CFP, NIDEK AFC-230 fundus camera: 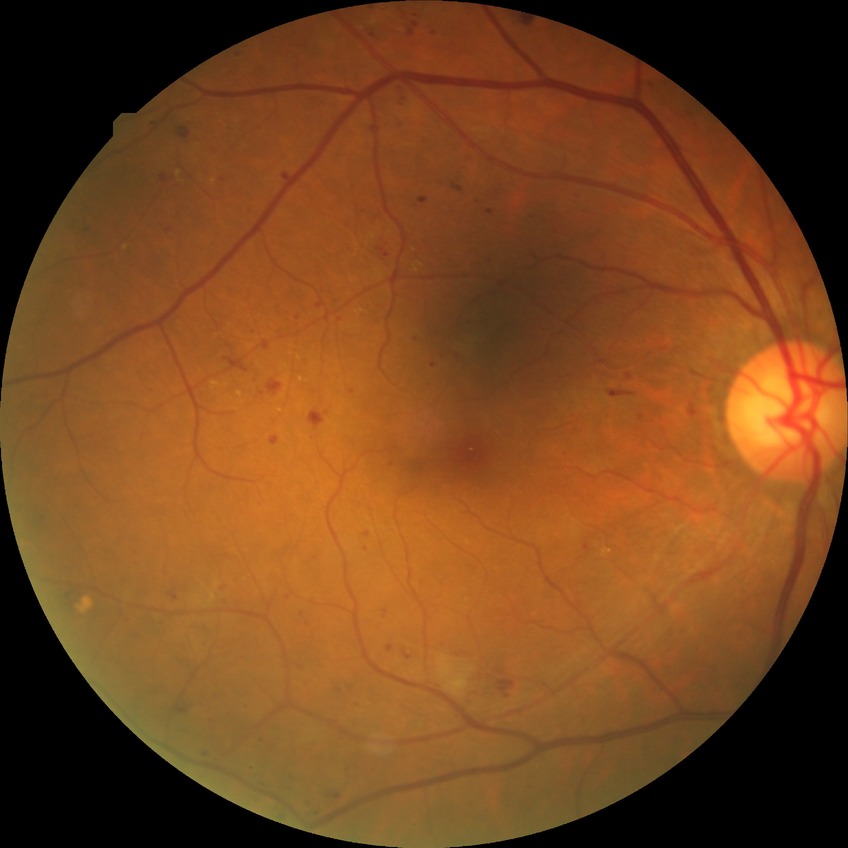

DR grade is SDR.